Color fundus photograph; 848x848px; graded on the modified Davis scale — 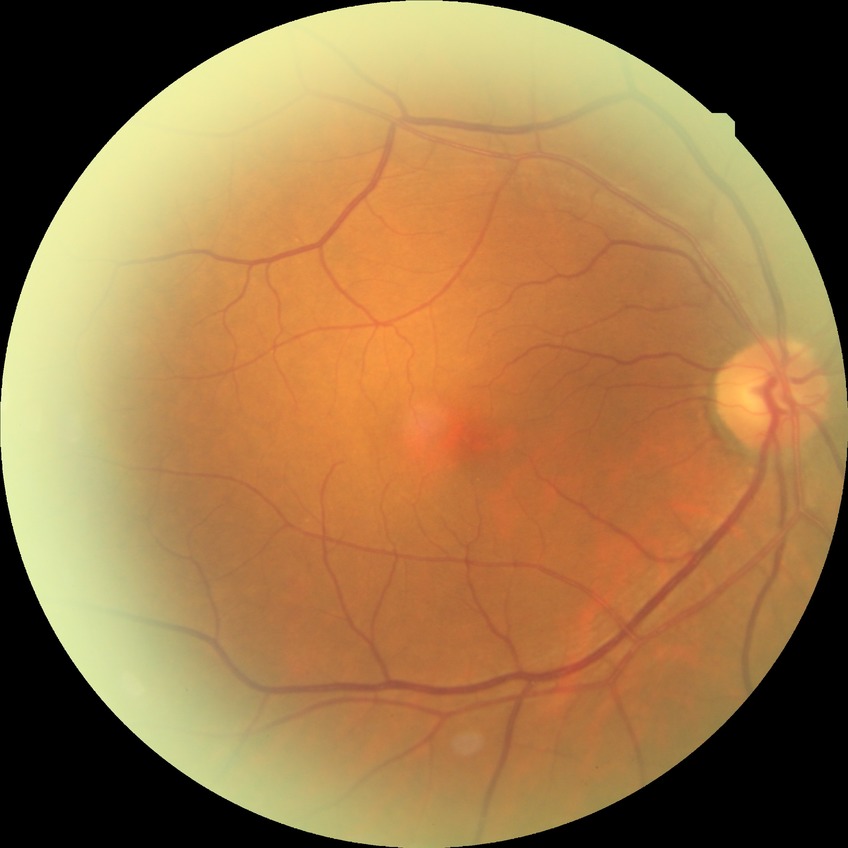

{
  "davis_grade": "NDR (no diabetic retinopathy)"
}